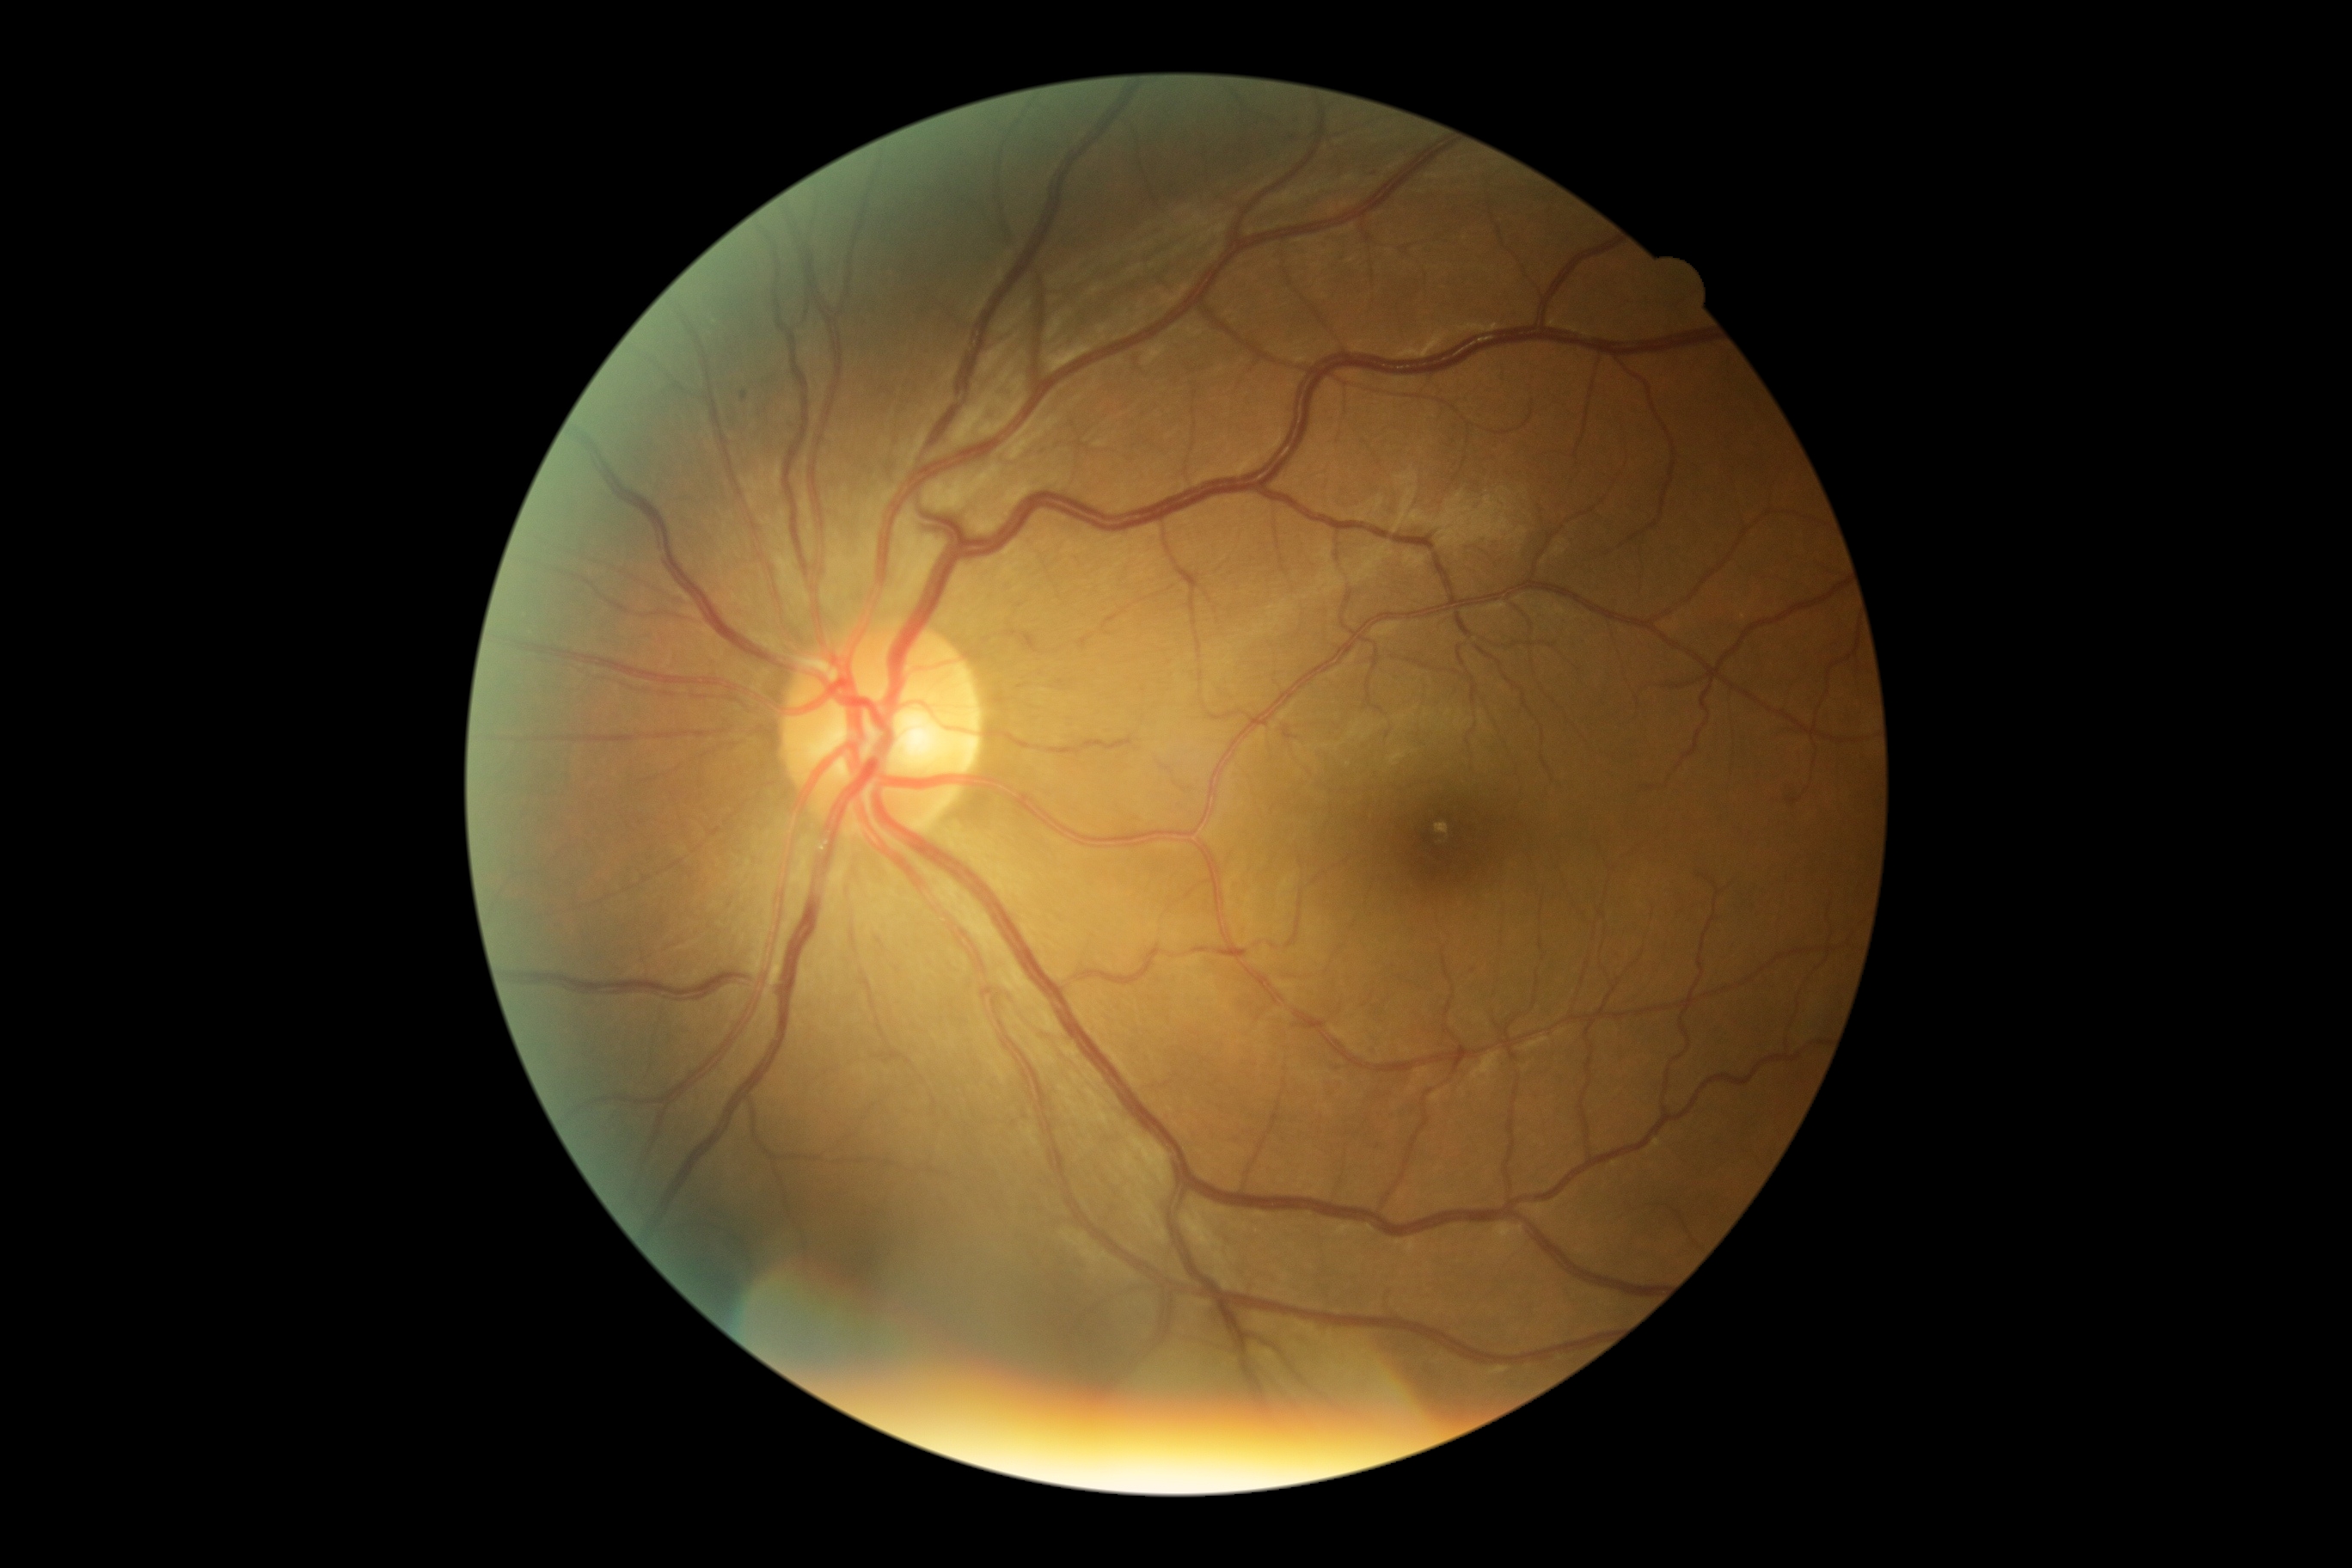
Diabetic retinopathy is 1/4.
Disease class: non-proliferative diabetic retinopathy.